2361 x 1568 pixels · tabletop color fundus camera image
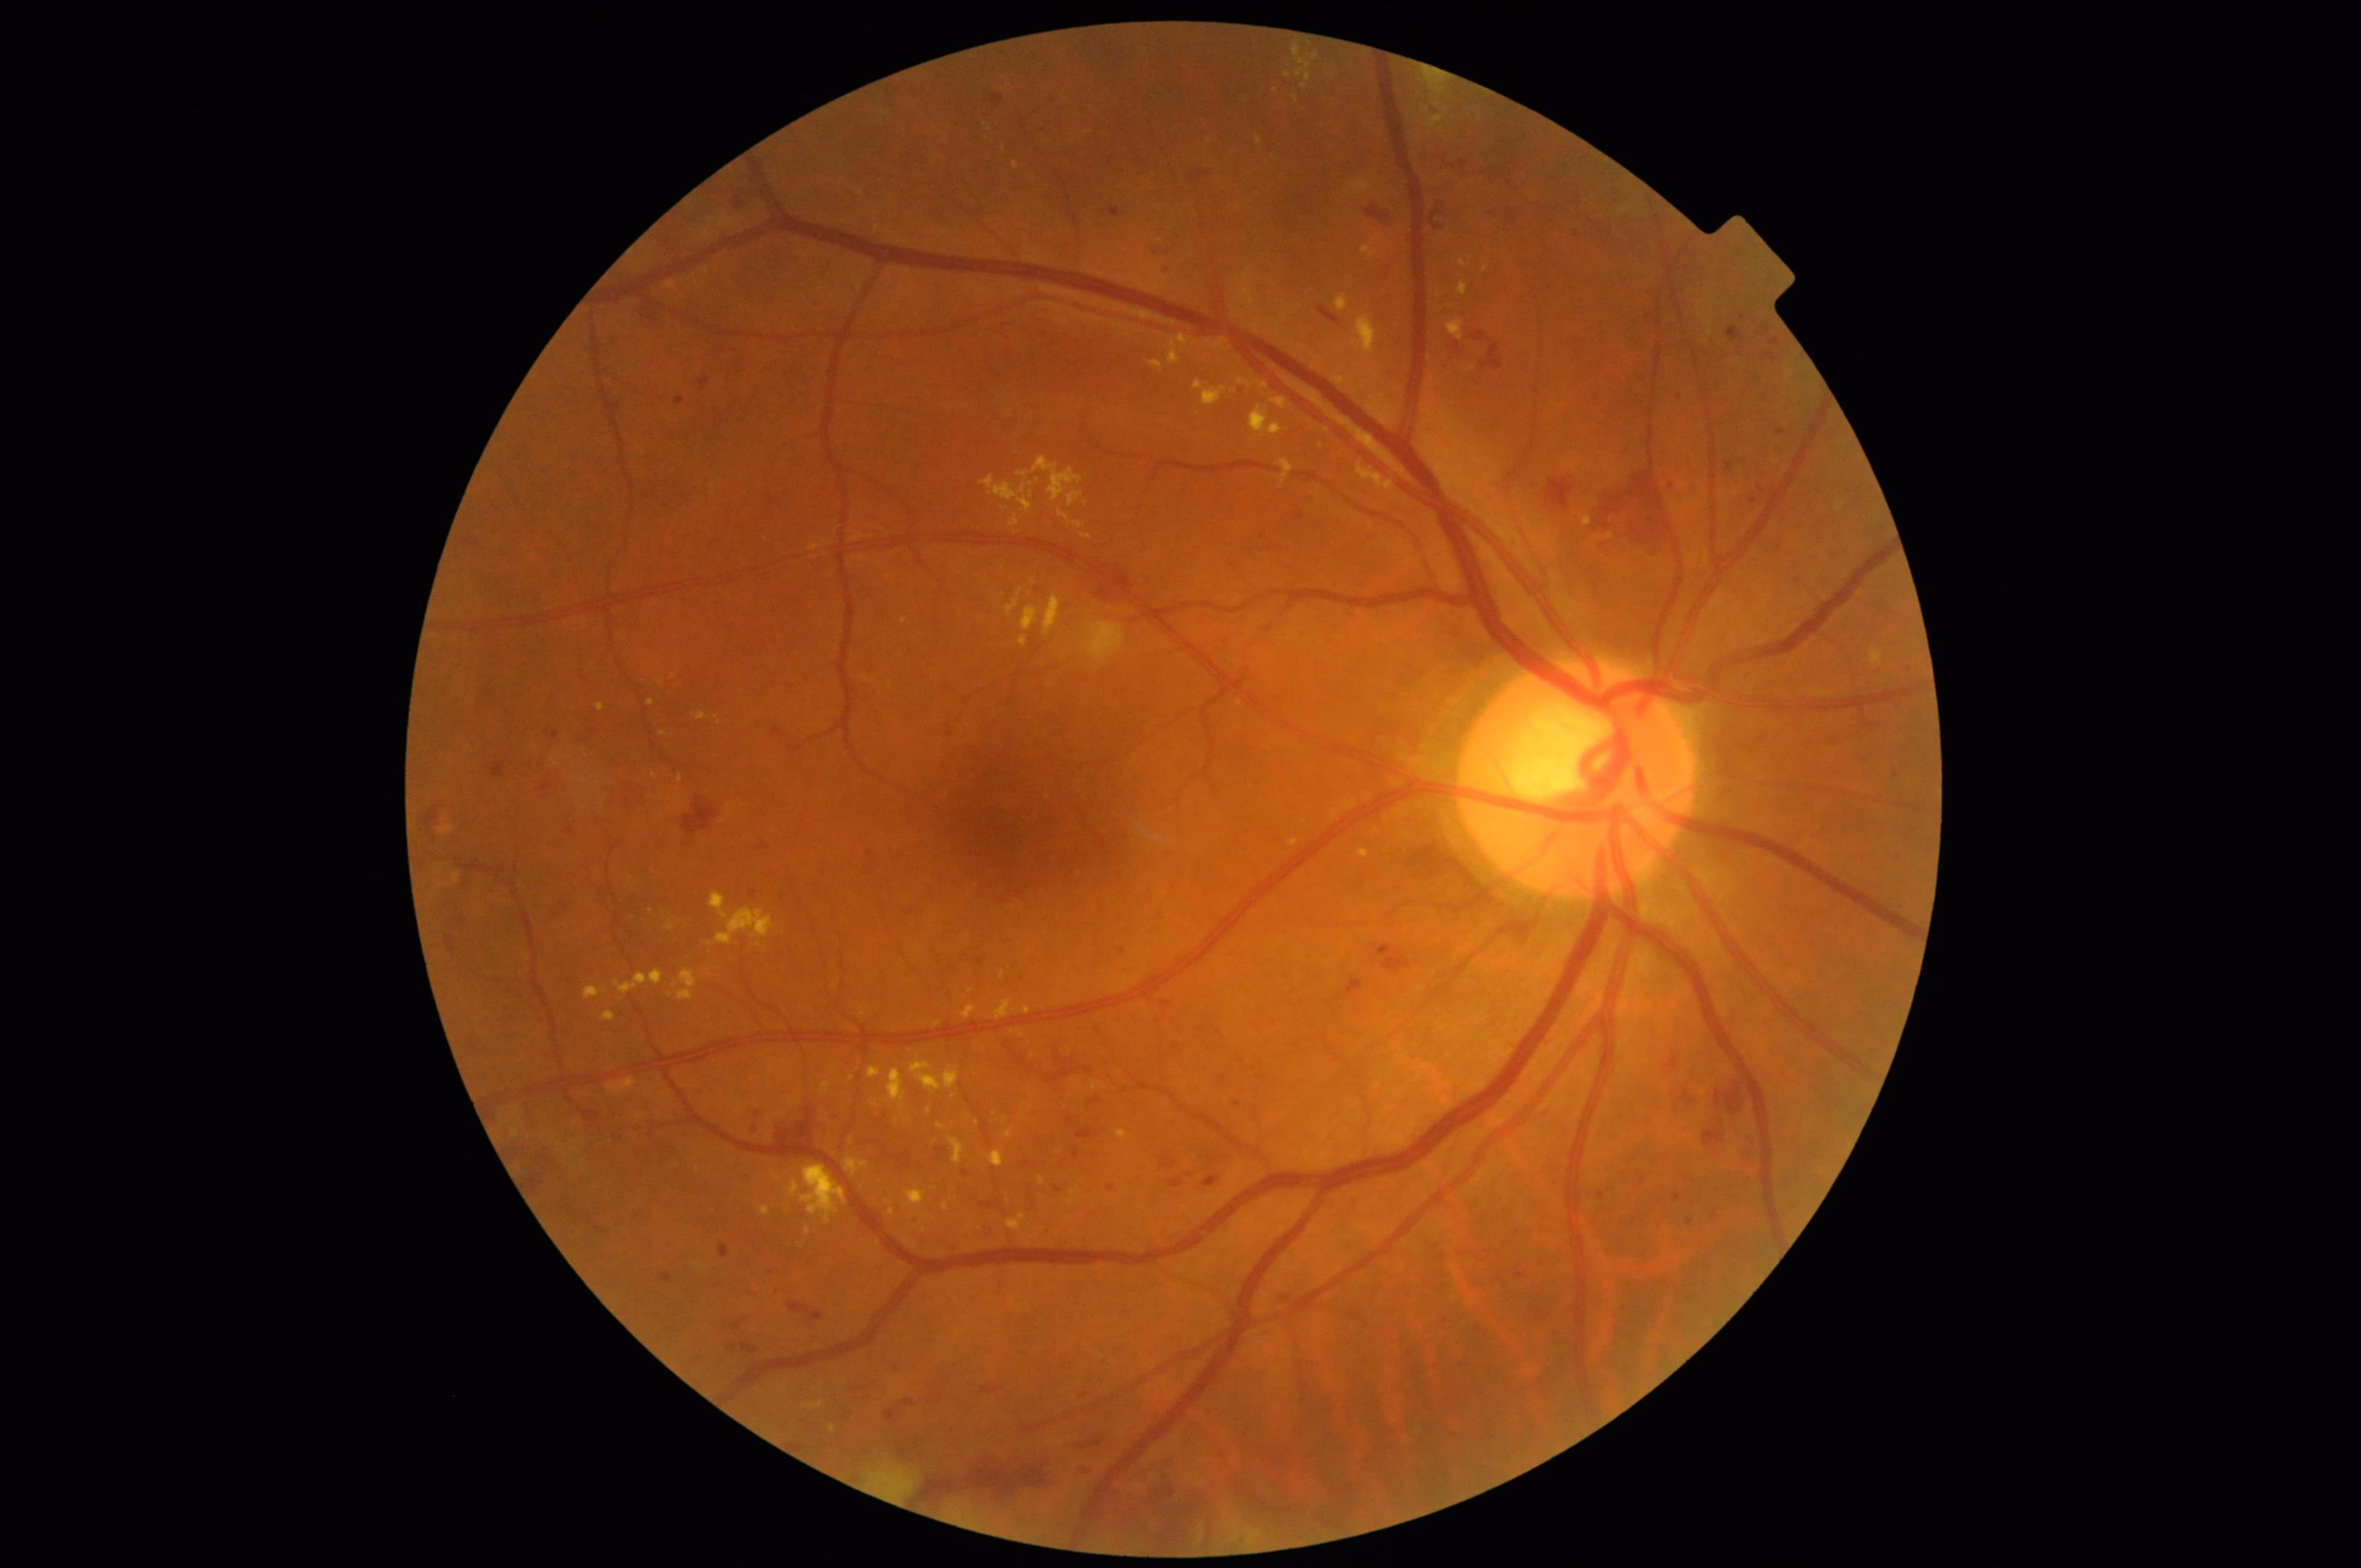

  overall_quality: adequate
  clarity: good